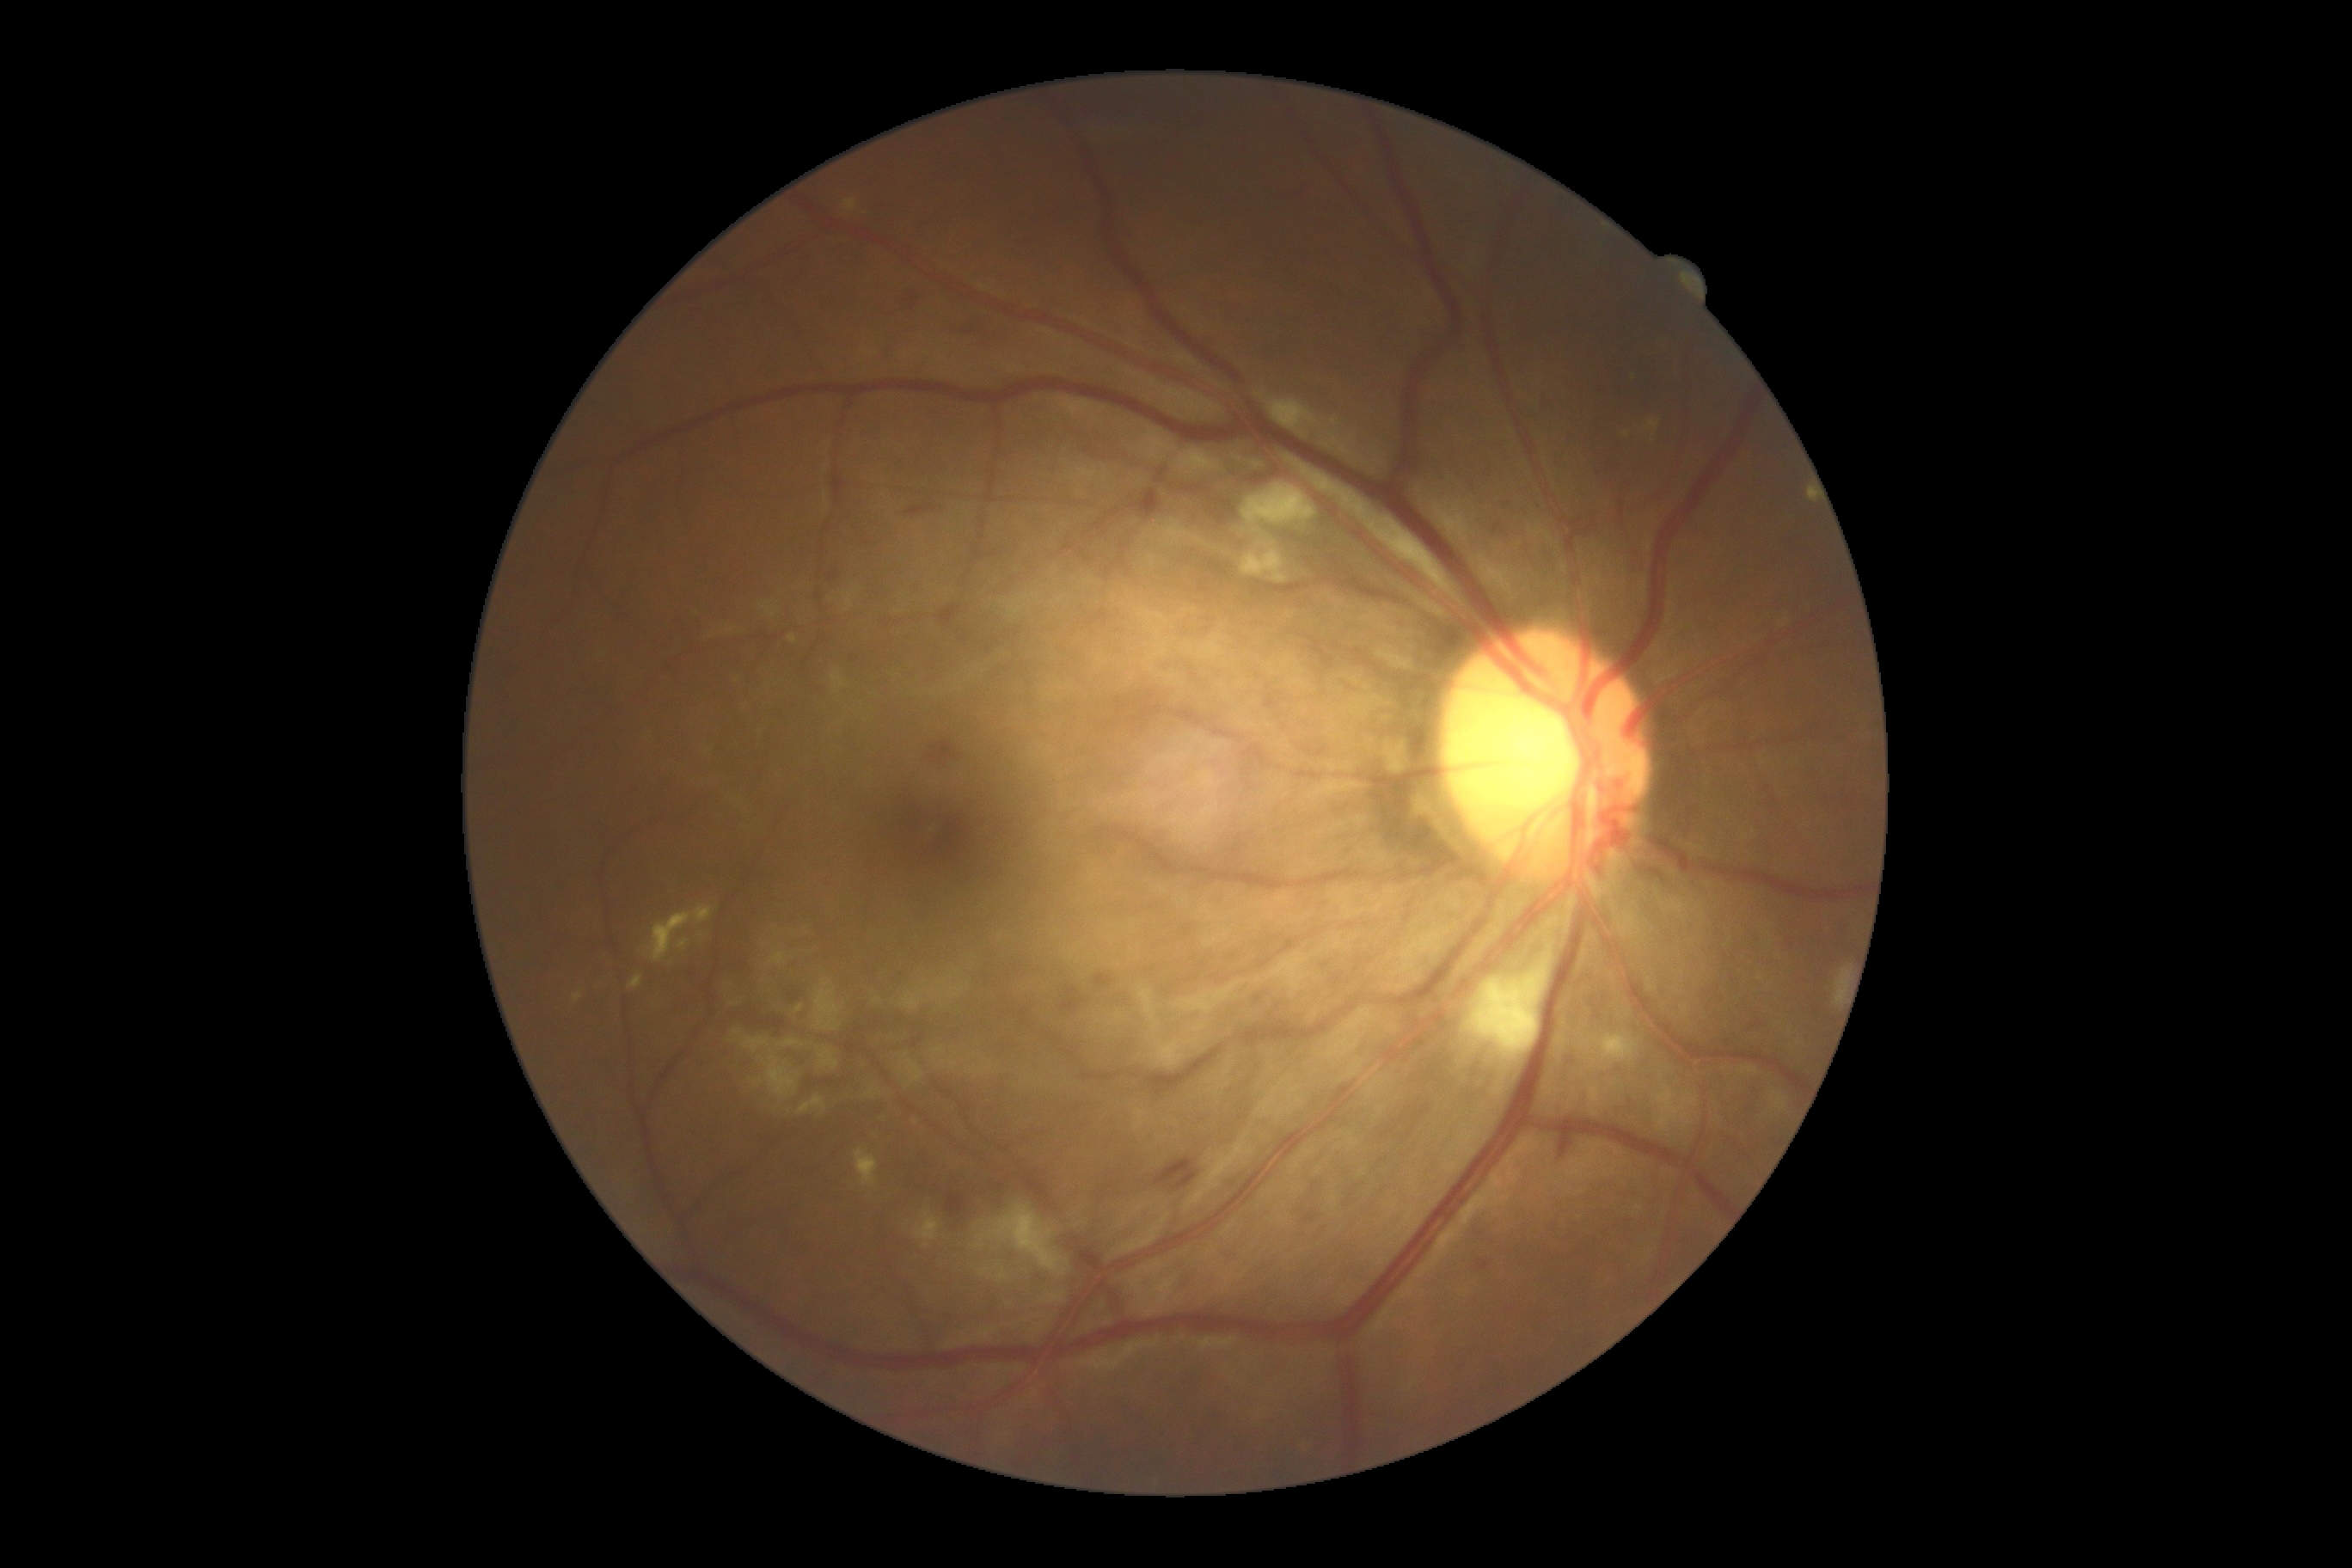 dr_grade: 2
dr_category: non-proliferative diabetic retinopathy